45° field of view
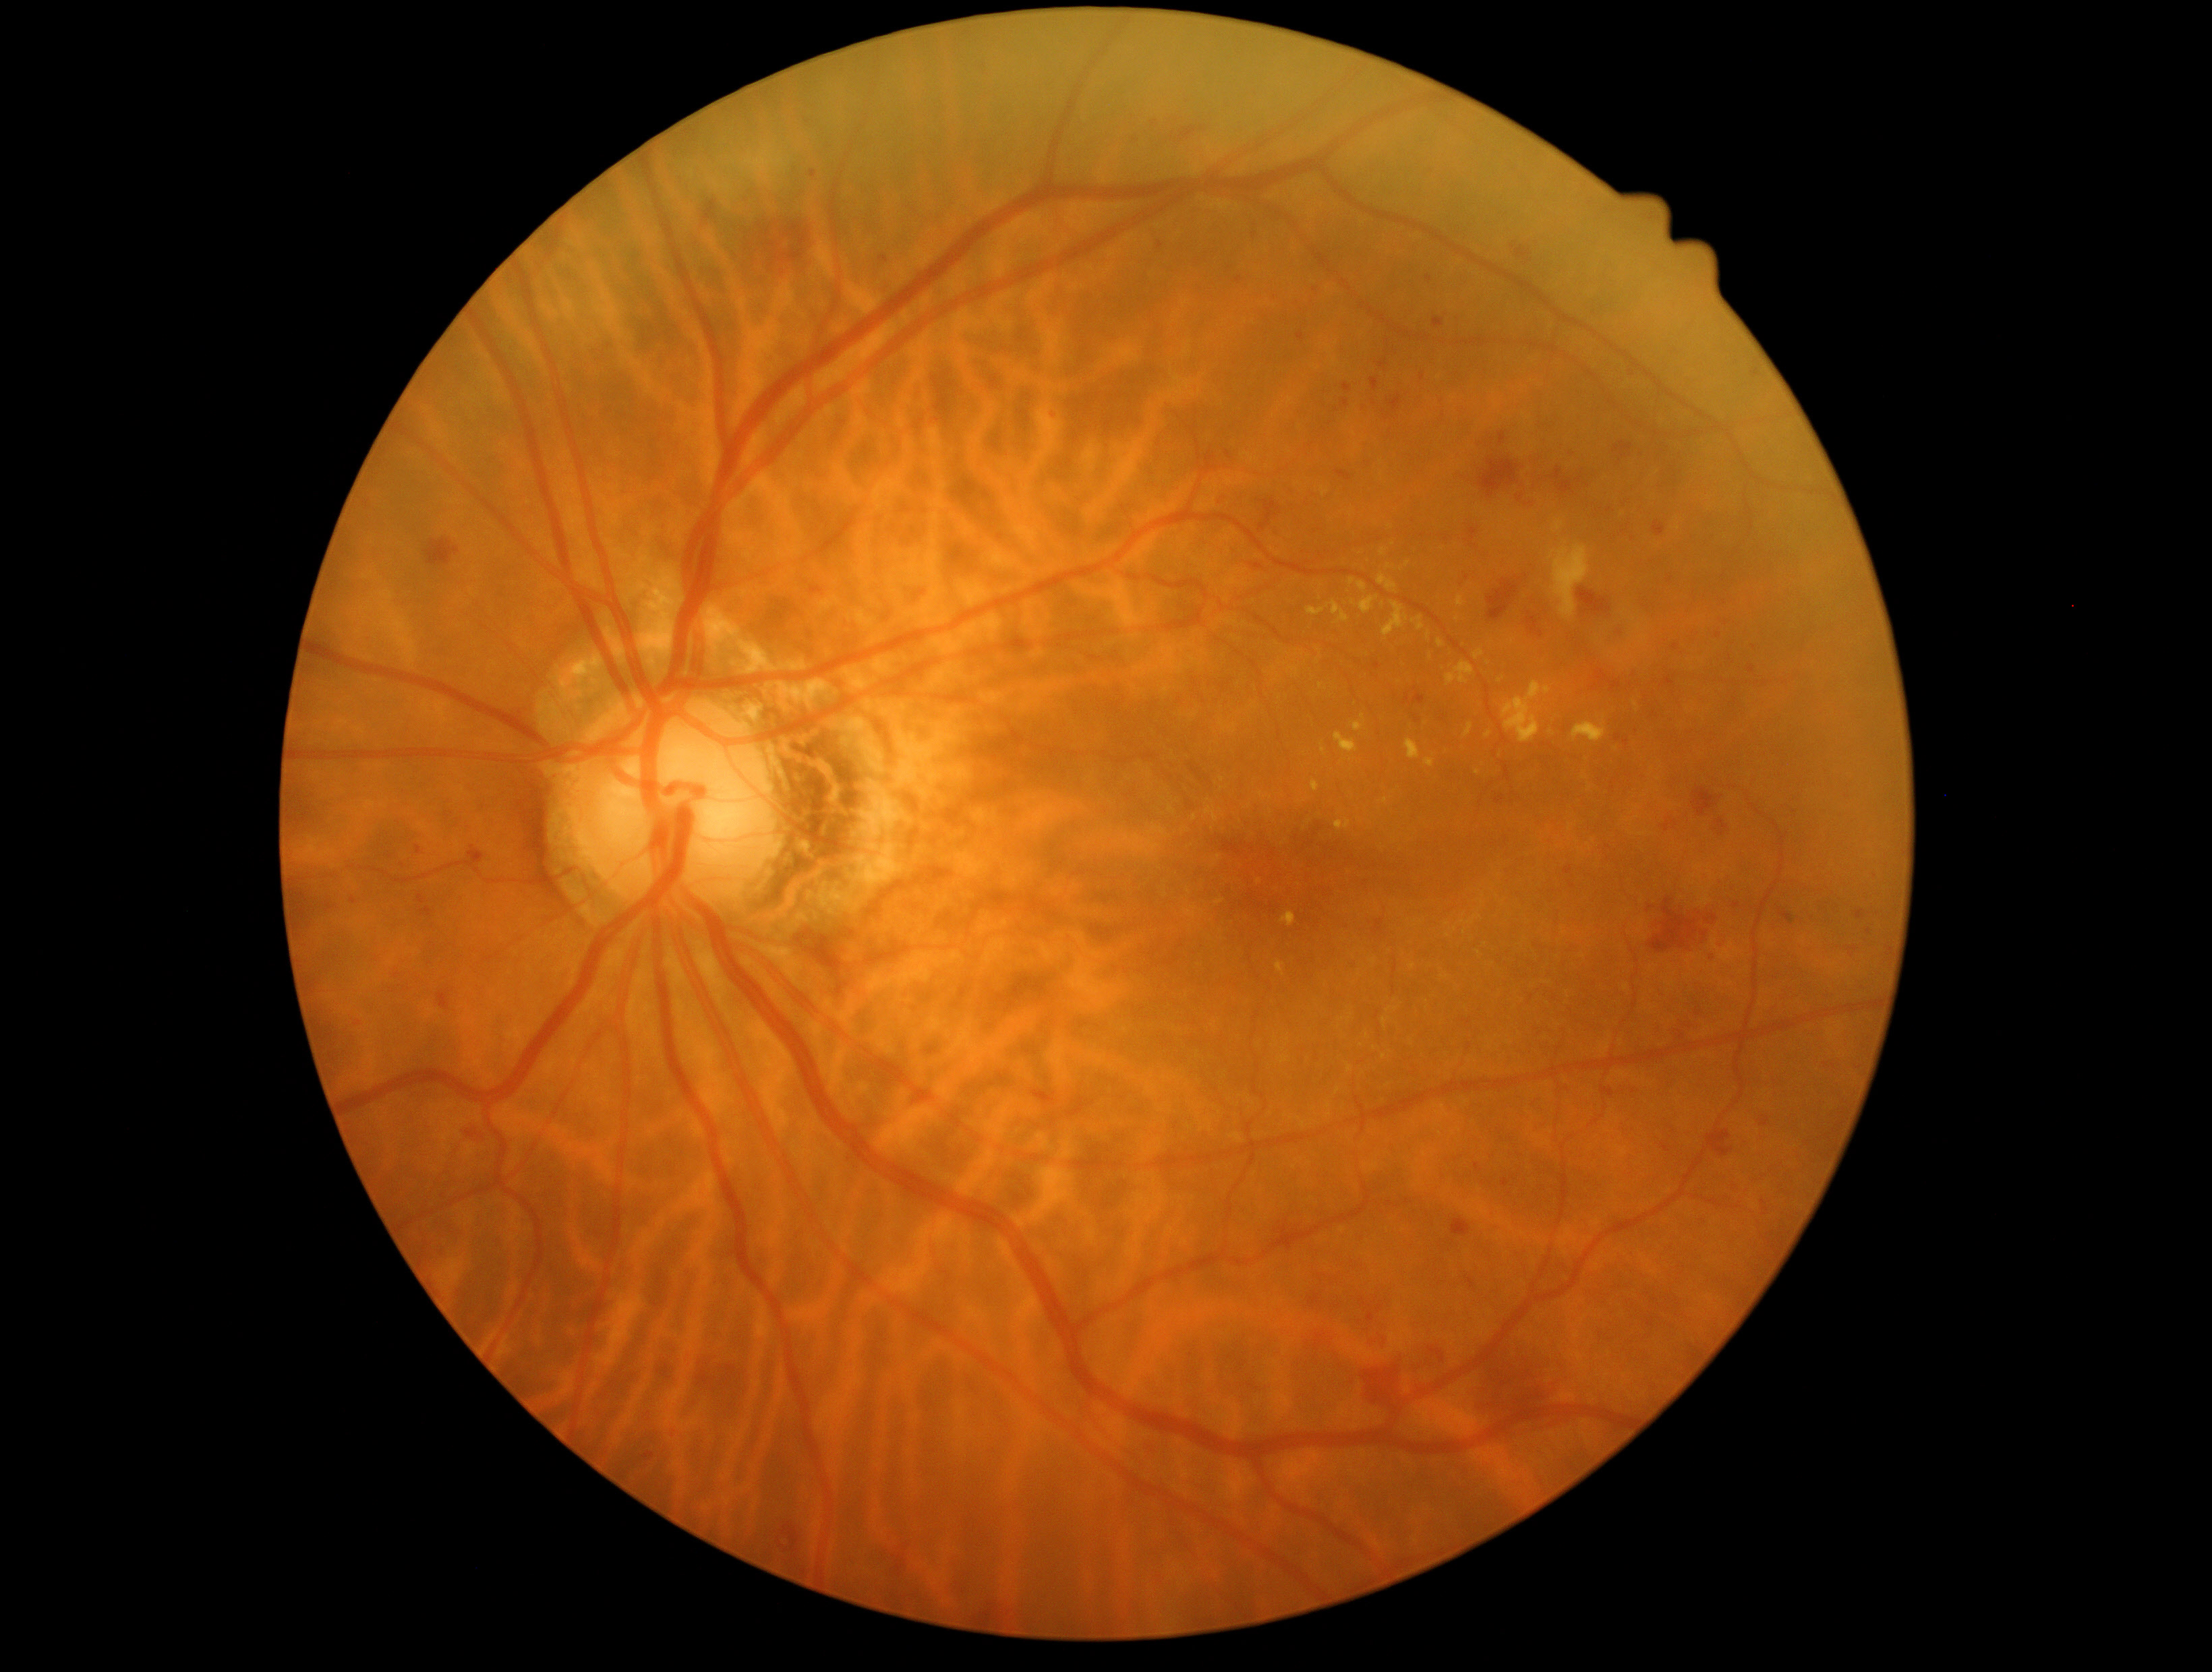
Diabetic retinopathy severity is 2
Representative lesions:
hard exudates (partial) = box=[1277, 962, 1285, 974] | box=[1426, 632, 1432, 641] | box=[1383, 1020, 1389, 1028] | box=[1548, 541, 1590, 621] | box=[1321, 748, 1325, 756] | box=[1445, 661, 1475, 686] | box=[1185, 911, 1196, 919] | box=[1378, 575, 1398, 593] | box=[1413, 617, 1425, 632] | box=[1553, 521, 1564, 535] | box=[1437, 640, 1444, 649]
Additional small hard exudates near x=1457, y=619 | x=1222, y=781 | x=1470, y=924 | x=1589, y=789 | x=1384, y=1057 | x=1353, y=604
microaneurysms = none
hemorrhages (partial) = box=[1855, 911, 1866, 920] | box=[349, 1017, 365, 1028] | box=[1297, 332, 1305, 343] | box=[1136, 1435, 1162, 1464] | box=[1341, 400, 1349, 408] | box=[1467, 527, 1479, 548] | box=[1615, 736, 1622, 744] | box=[1351, 1292, 1386, 1326] | box=[463, 847, 484, 866] | box=[801, 576, 823, 599] | box=[1653, 521, 1666, 537] | box=[1840, 789, 1854, 800] | box=[1452, 425, 1633, 512] | box=[1843, 943, 1862, 961]
Additional small hemorrhages near x=1608, y=510 | x=1429, y=279 | x=1422, y=377 | x=1612, y=789
soft exudates = none